Color fundus photograph:
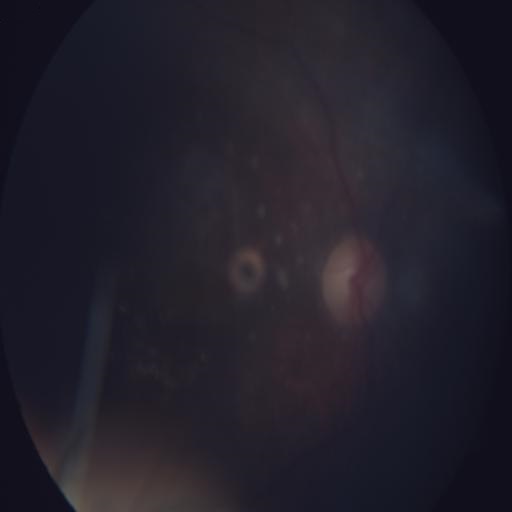
The image shows EDN (exudation) and CWS (cotton wool spots).